Optic nerve head photograph.
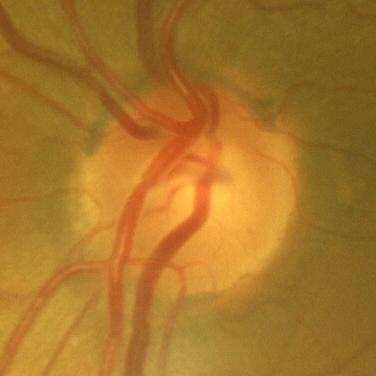
Optic disc appearance consistent with no glaucomatous changes.